Modified Davis grading, 848 x 848 pixels.
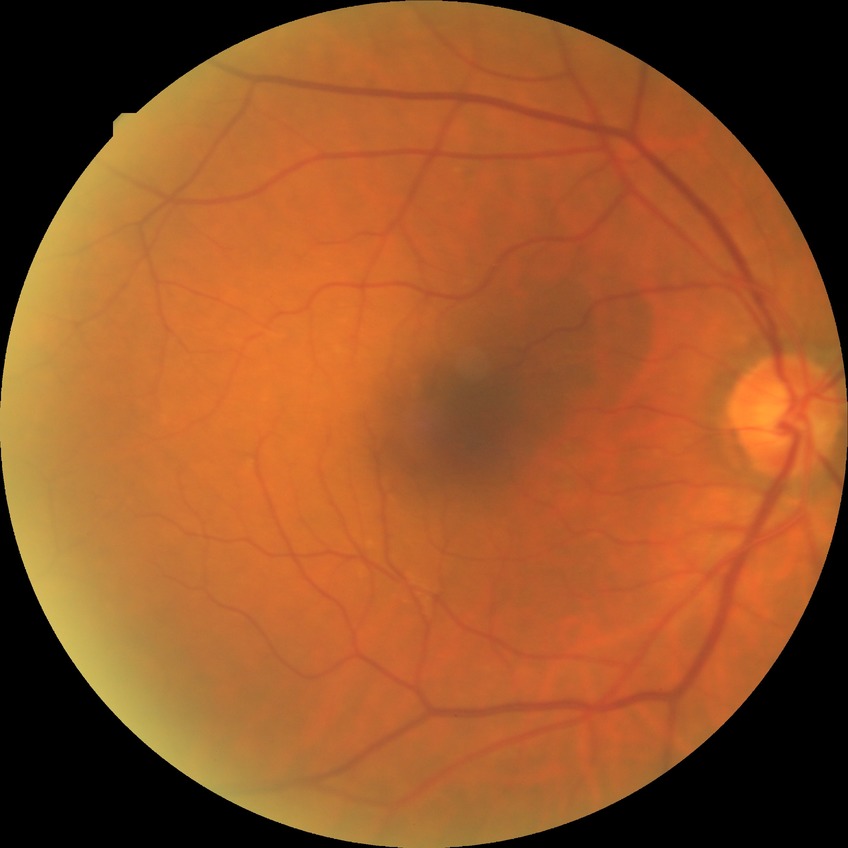 Assessment:
– retinopathy stage: no diabetic retinopathy